2228 x 1652 pixels.
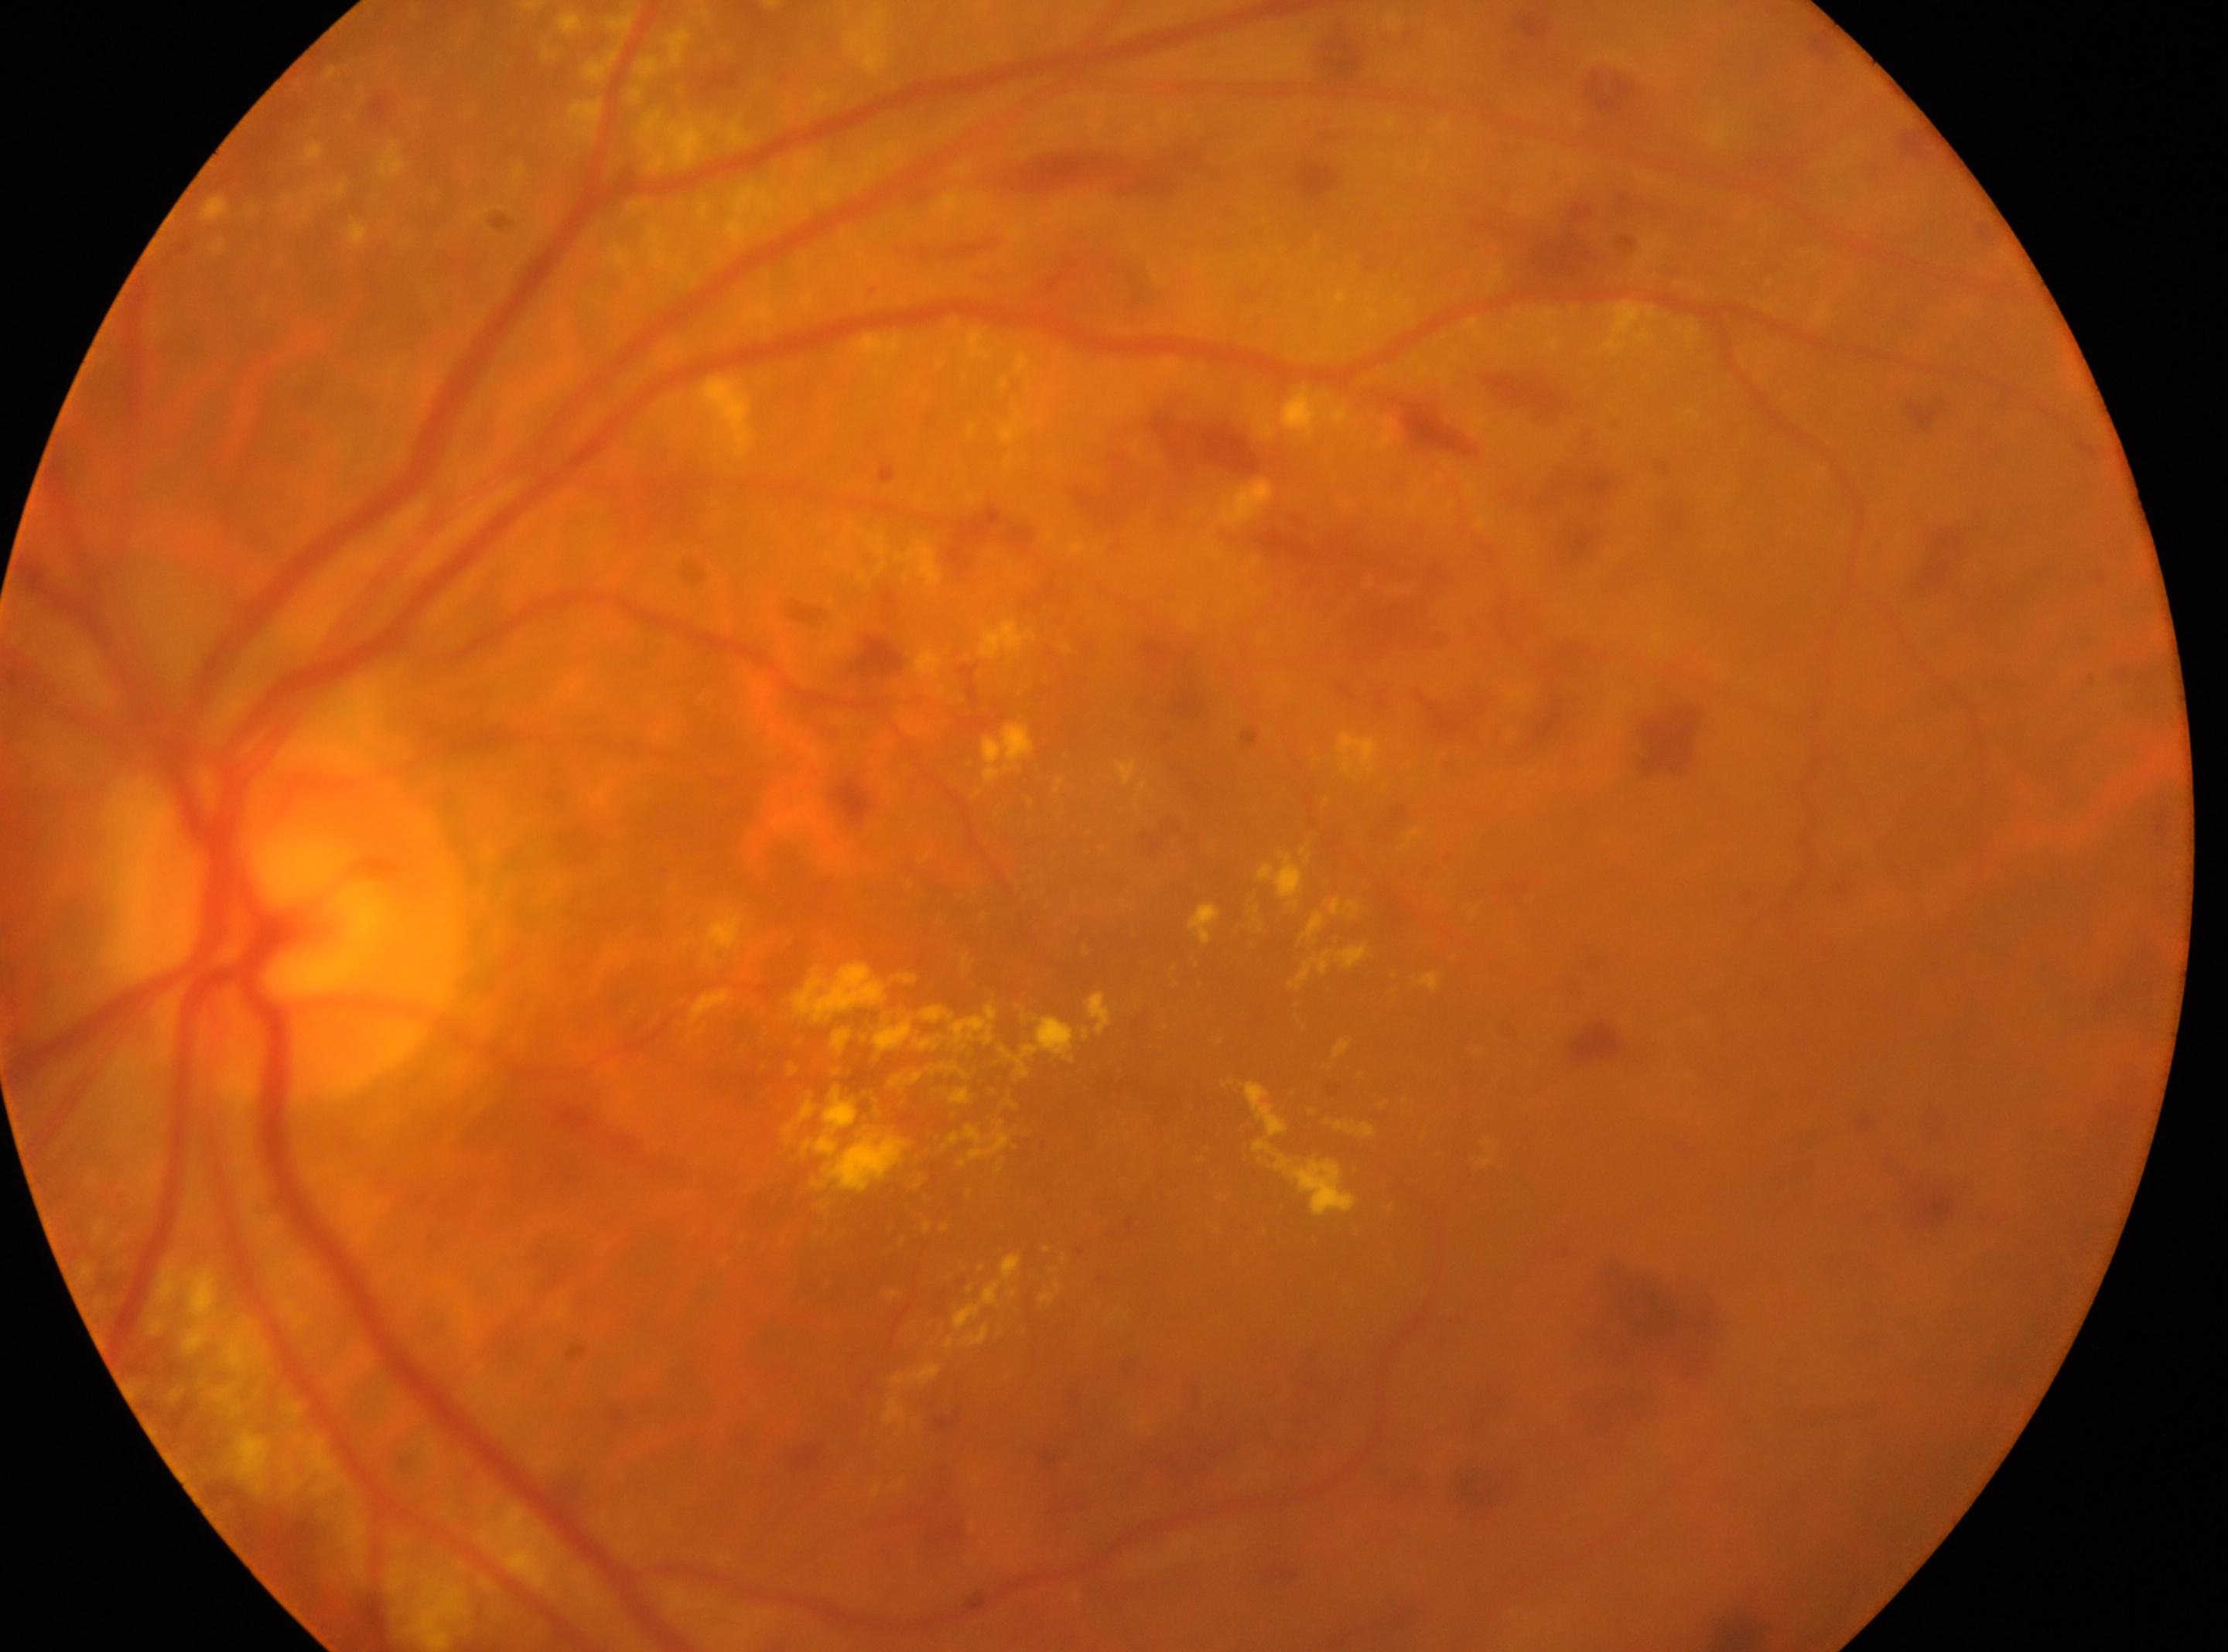
DR: severe NPDR (grade 3) | non-proliferative diabetic retinopathy | left | optic disk: (x: 292, y: 916) | foveal center: (x: 1139, y: 1097).